45° field of view · 2048x1536px · fundus photo:
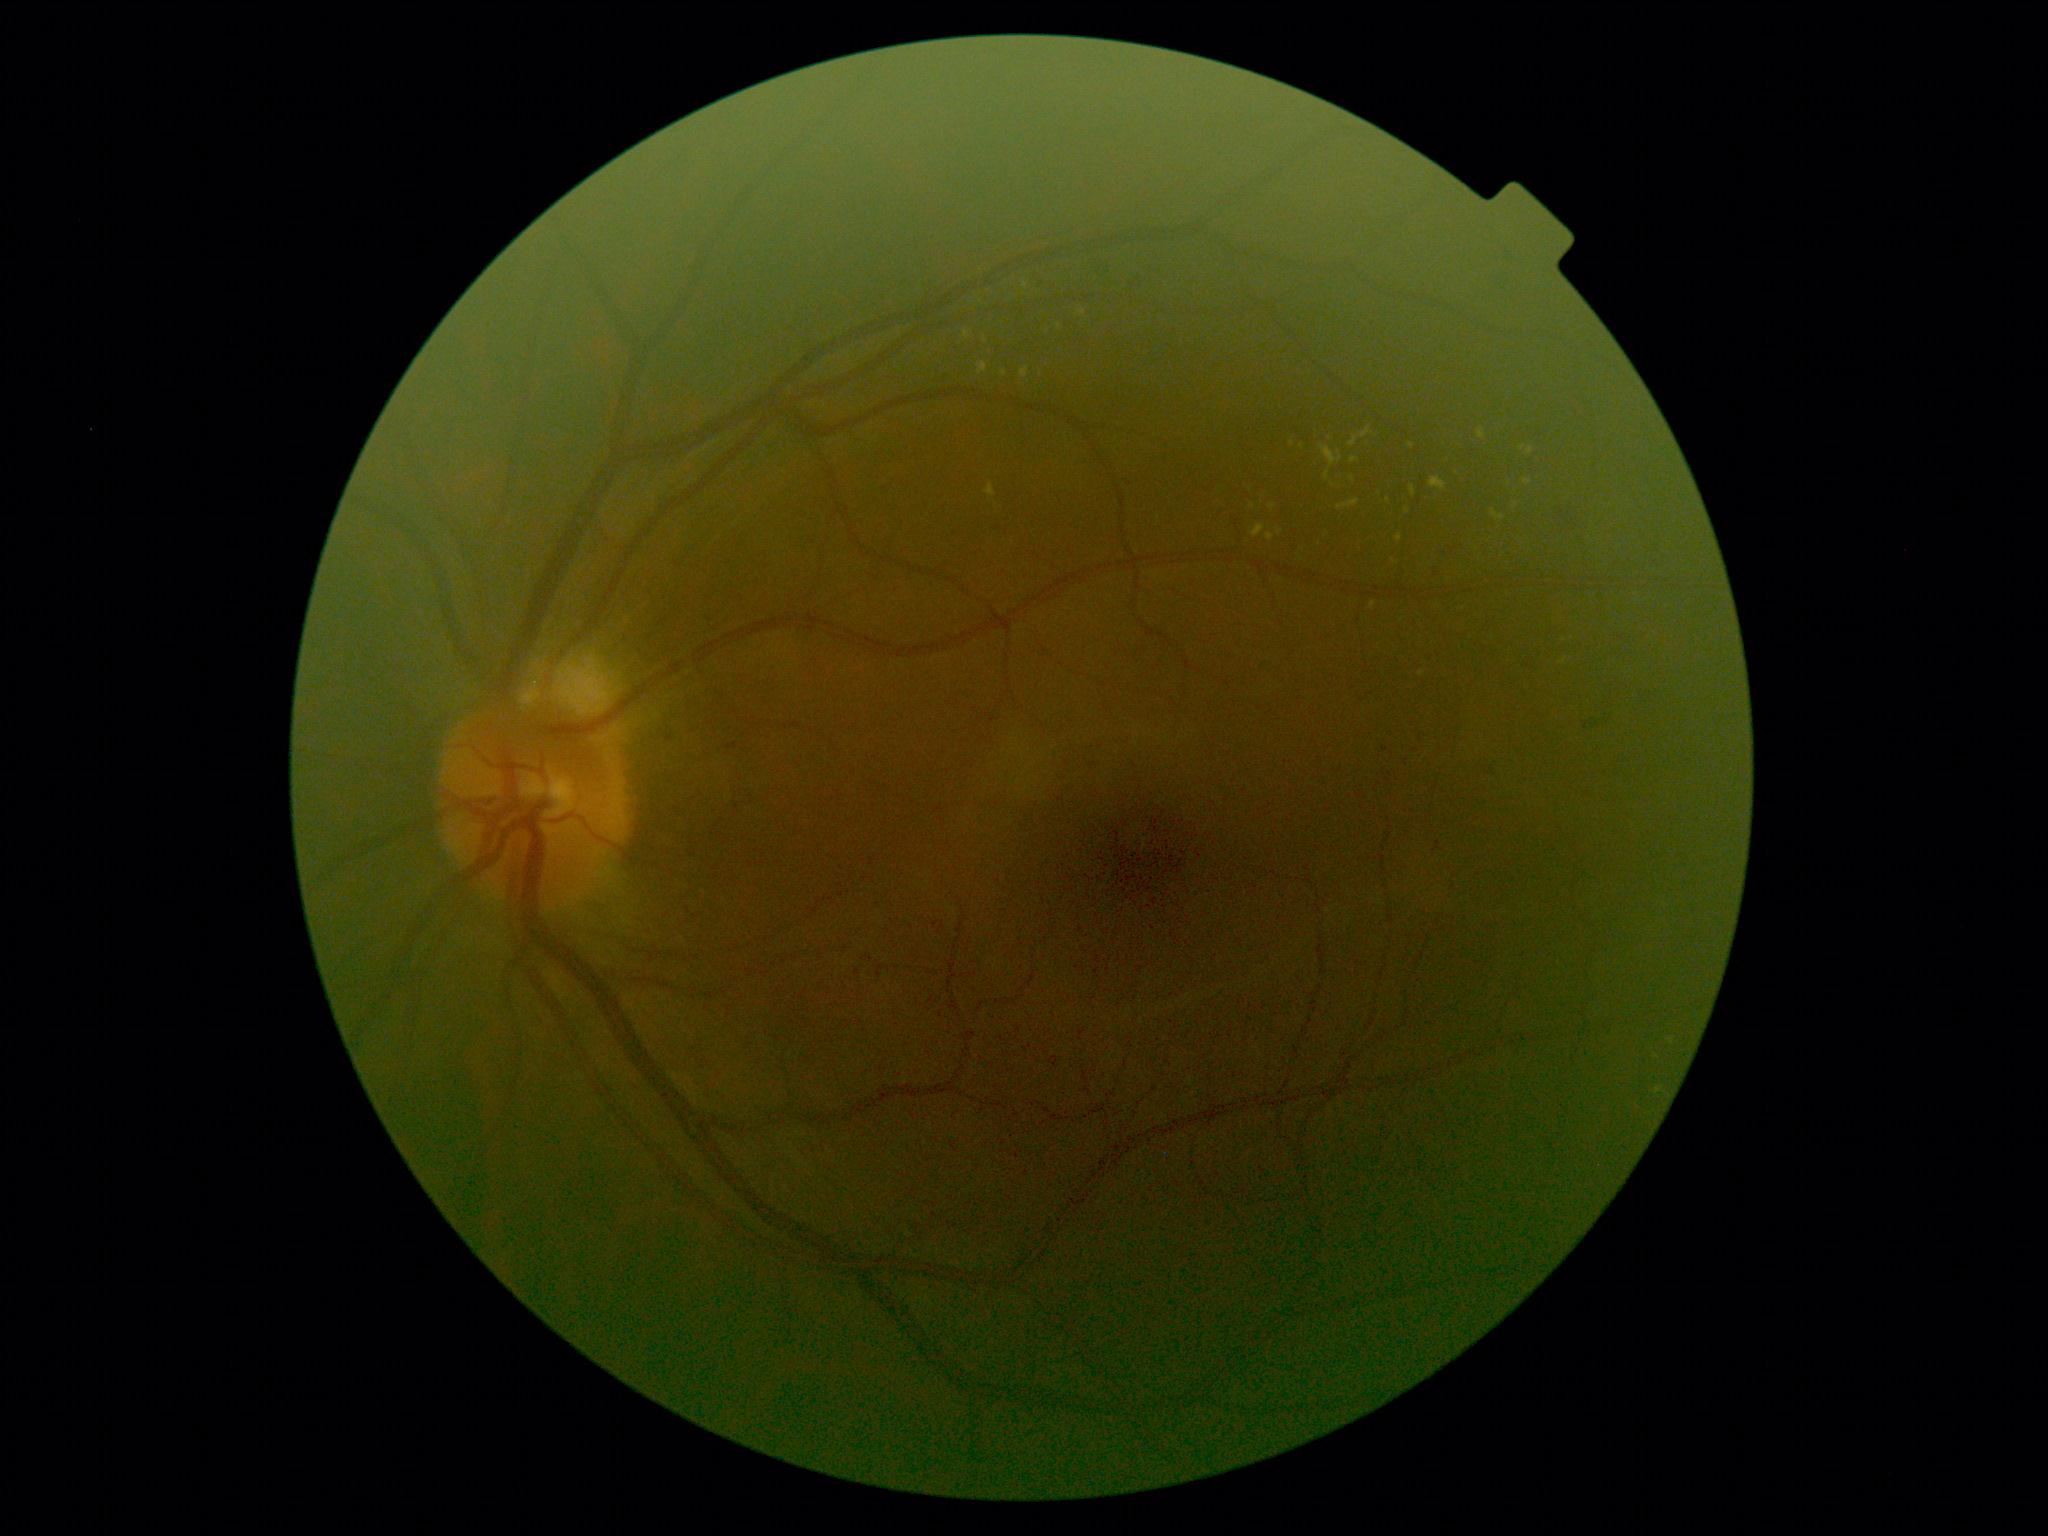 diabetic retinopathy (DR)=2 — more than just microaneurysms but less than severe NPDR.